Image size 848x848, FOV: 45 degrees
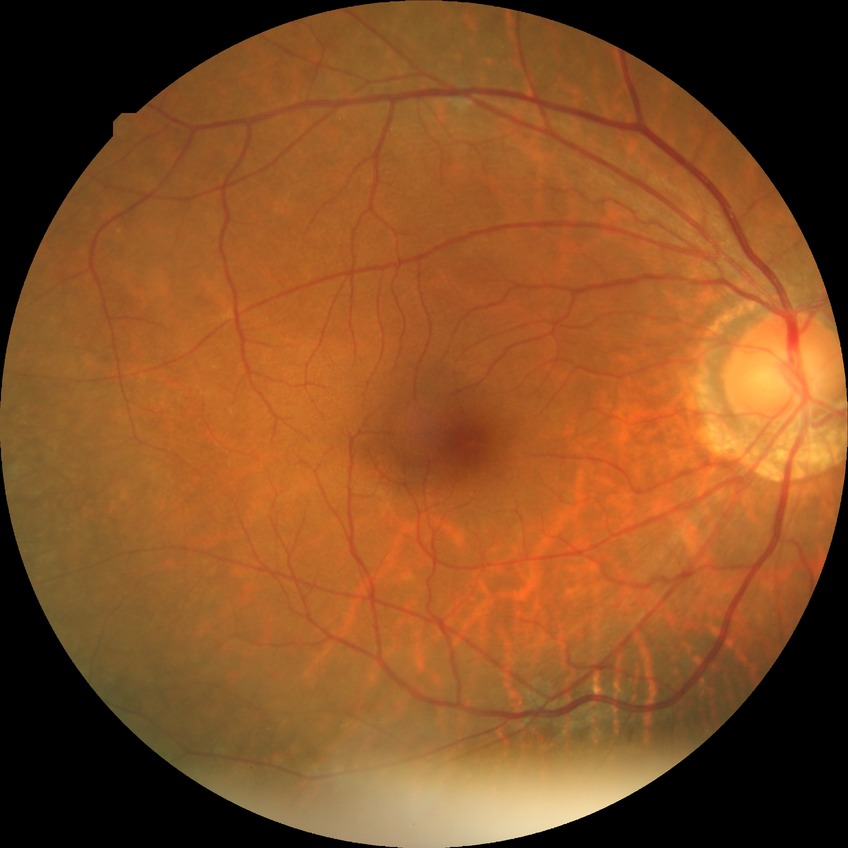 DR: NDR. No diabetic retinal disease findings.